2352 by 1568 pixels: 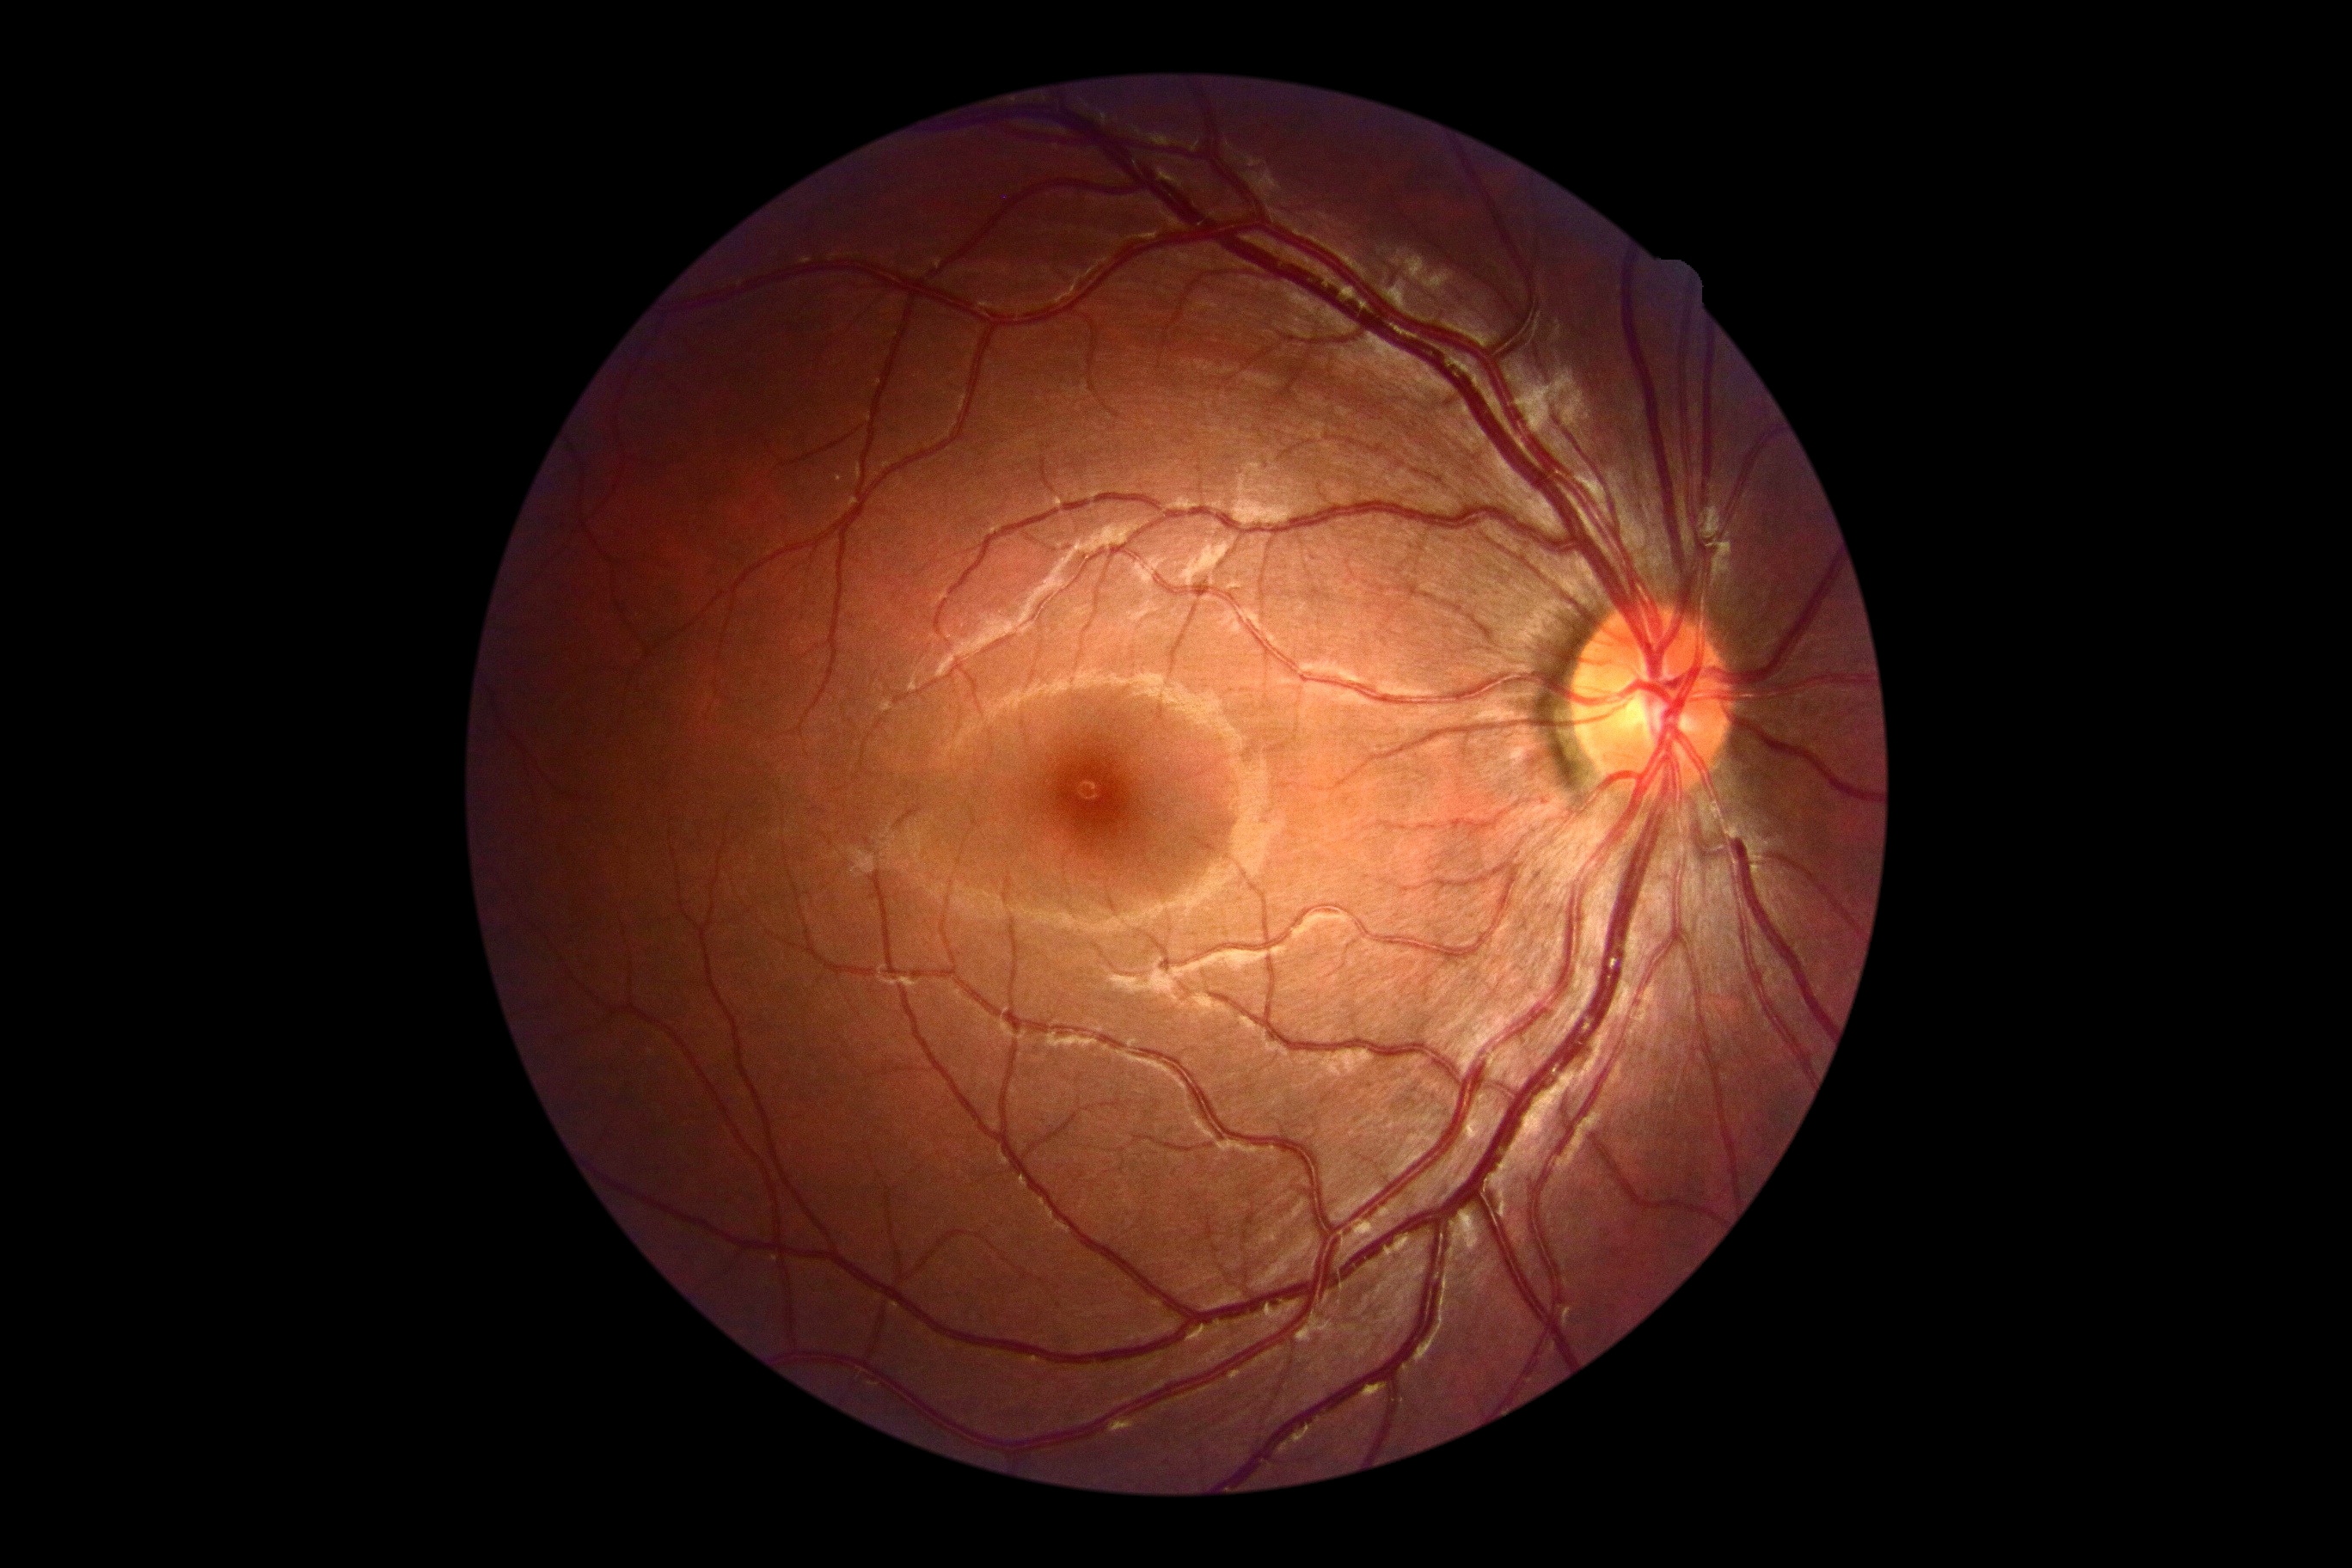 Findings:
– DR severity — grade 0 (no apparent retinopathy)